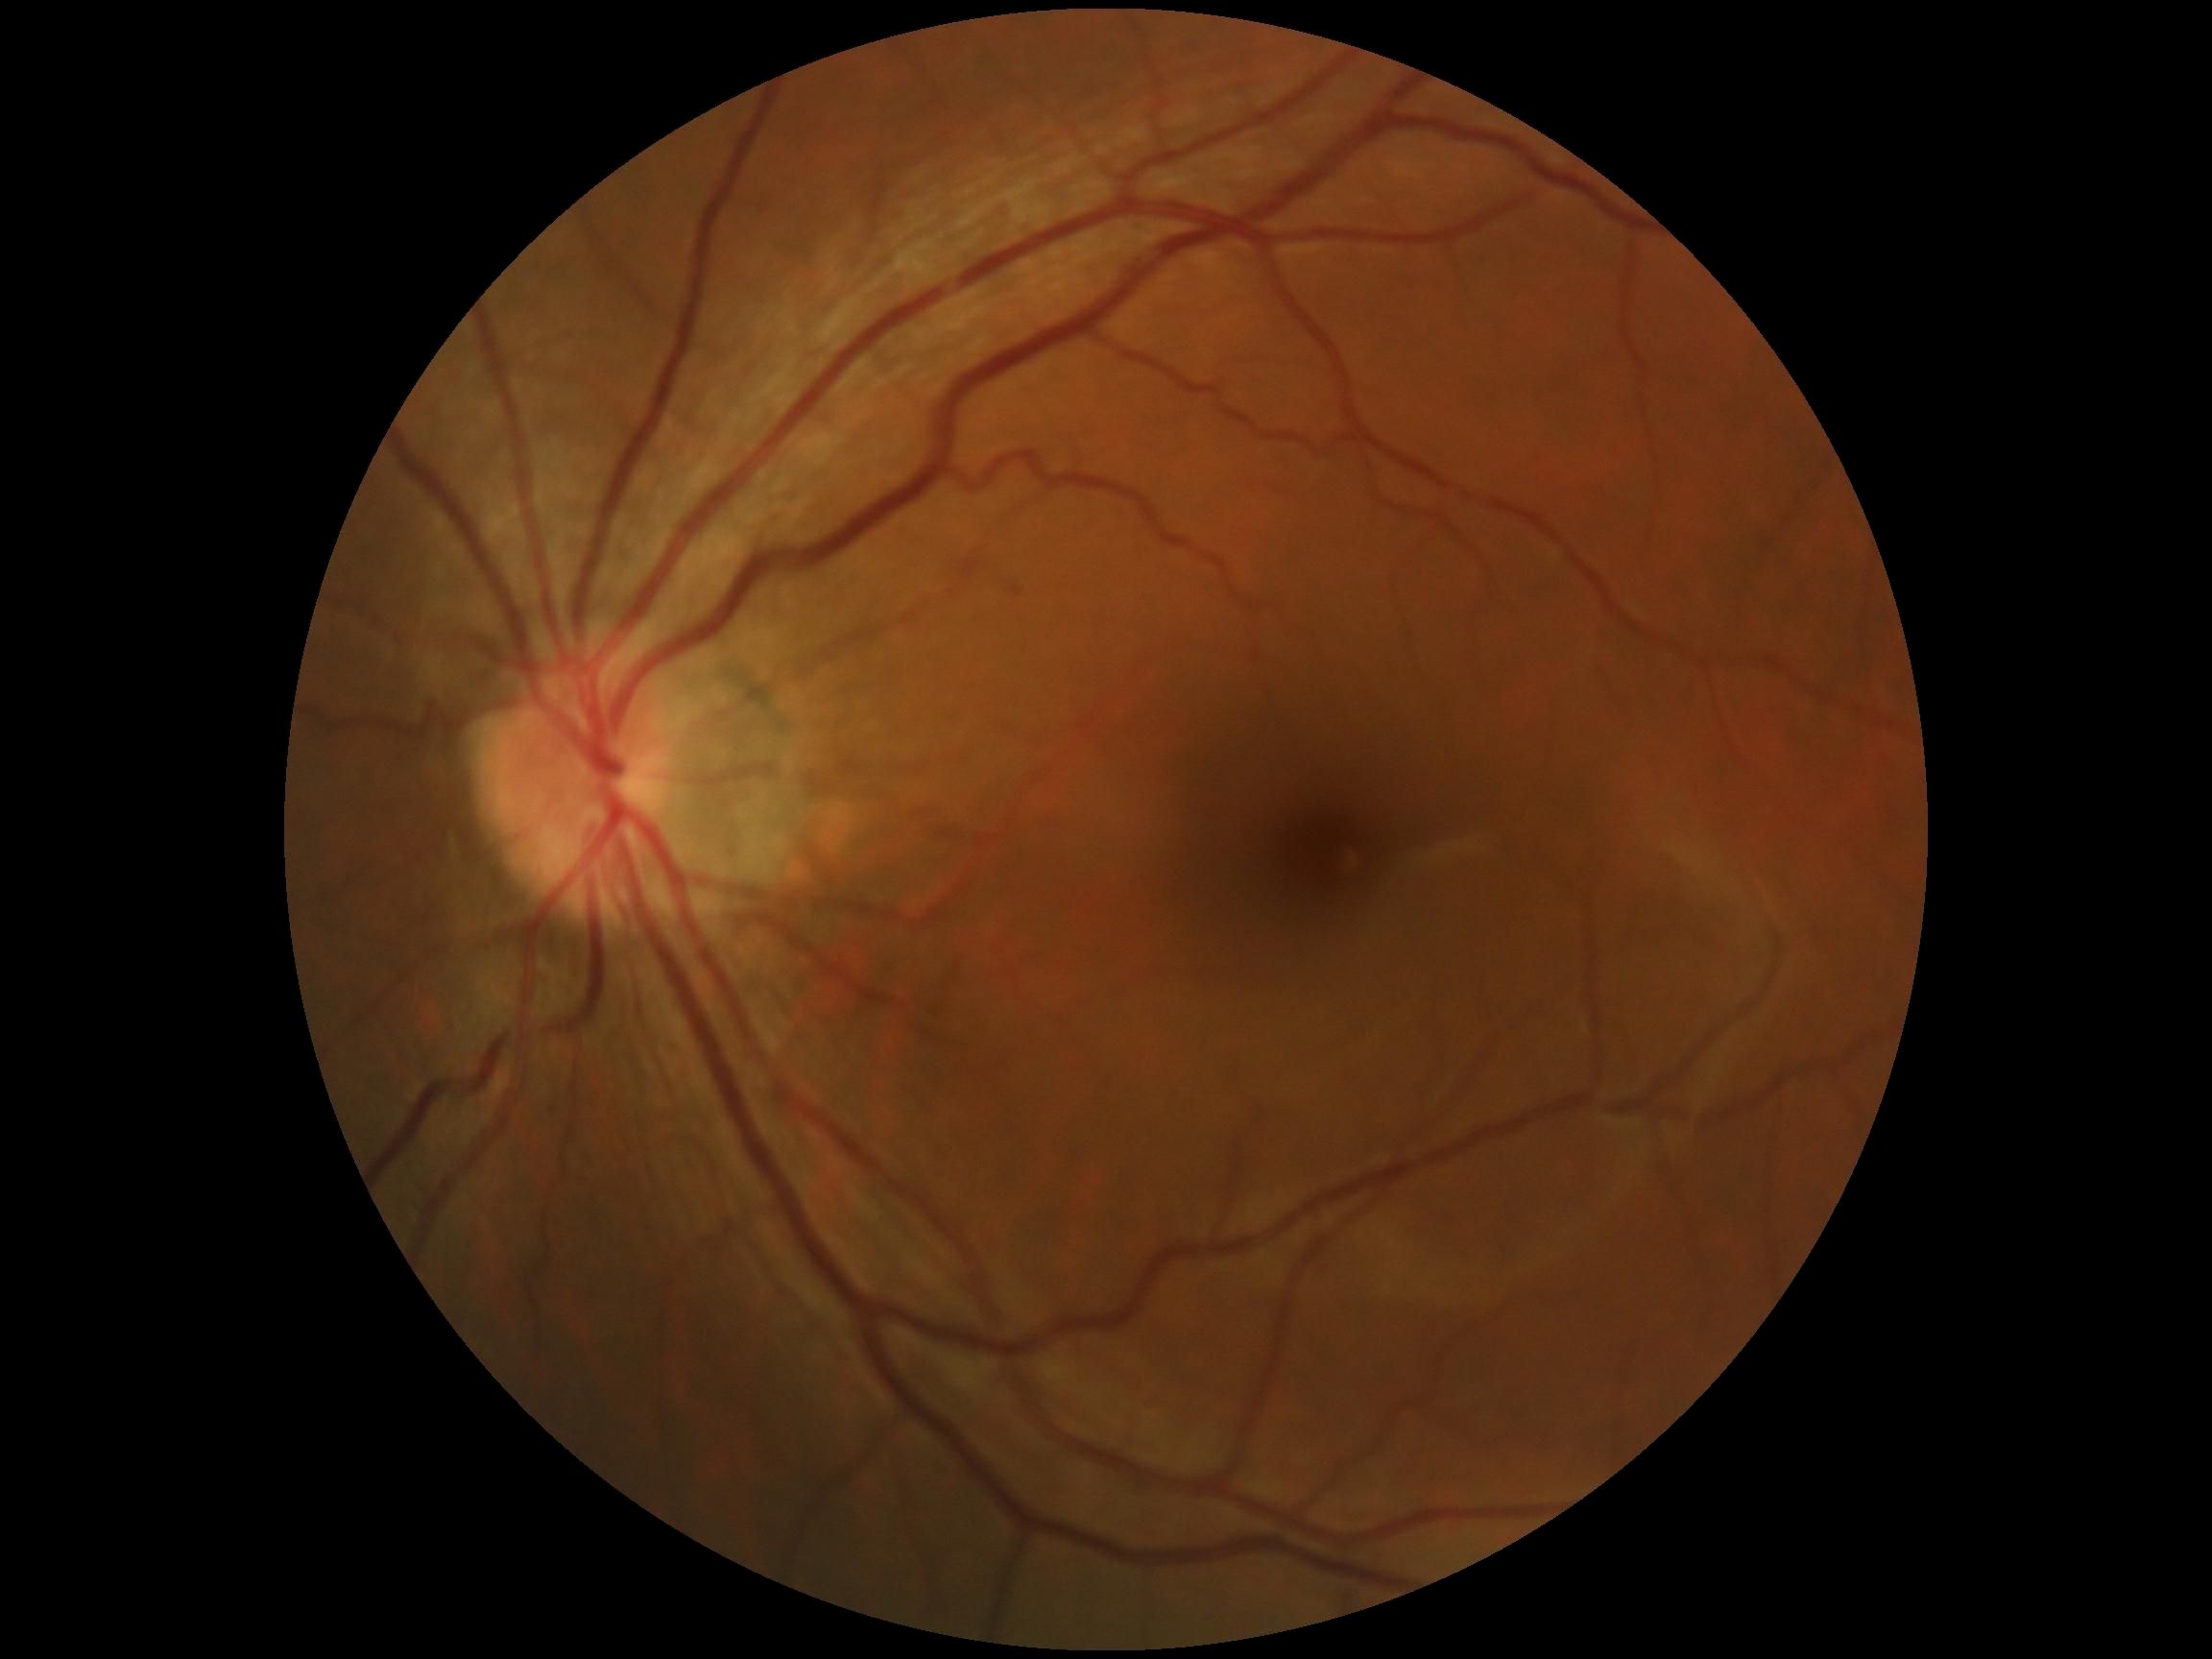

DR: grade 0.